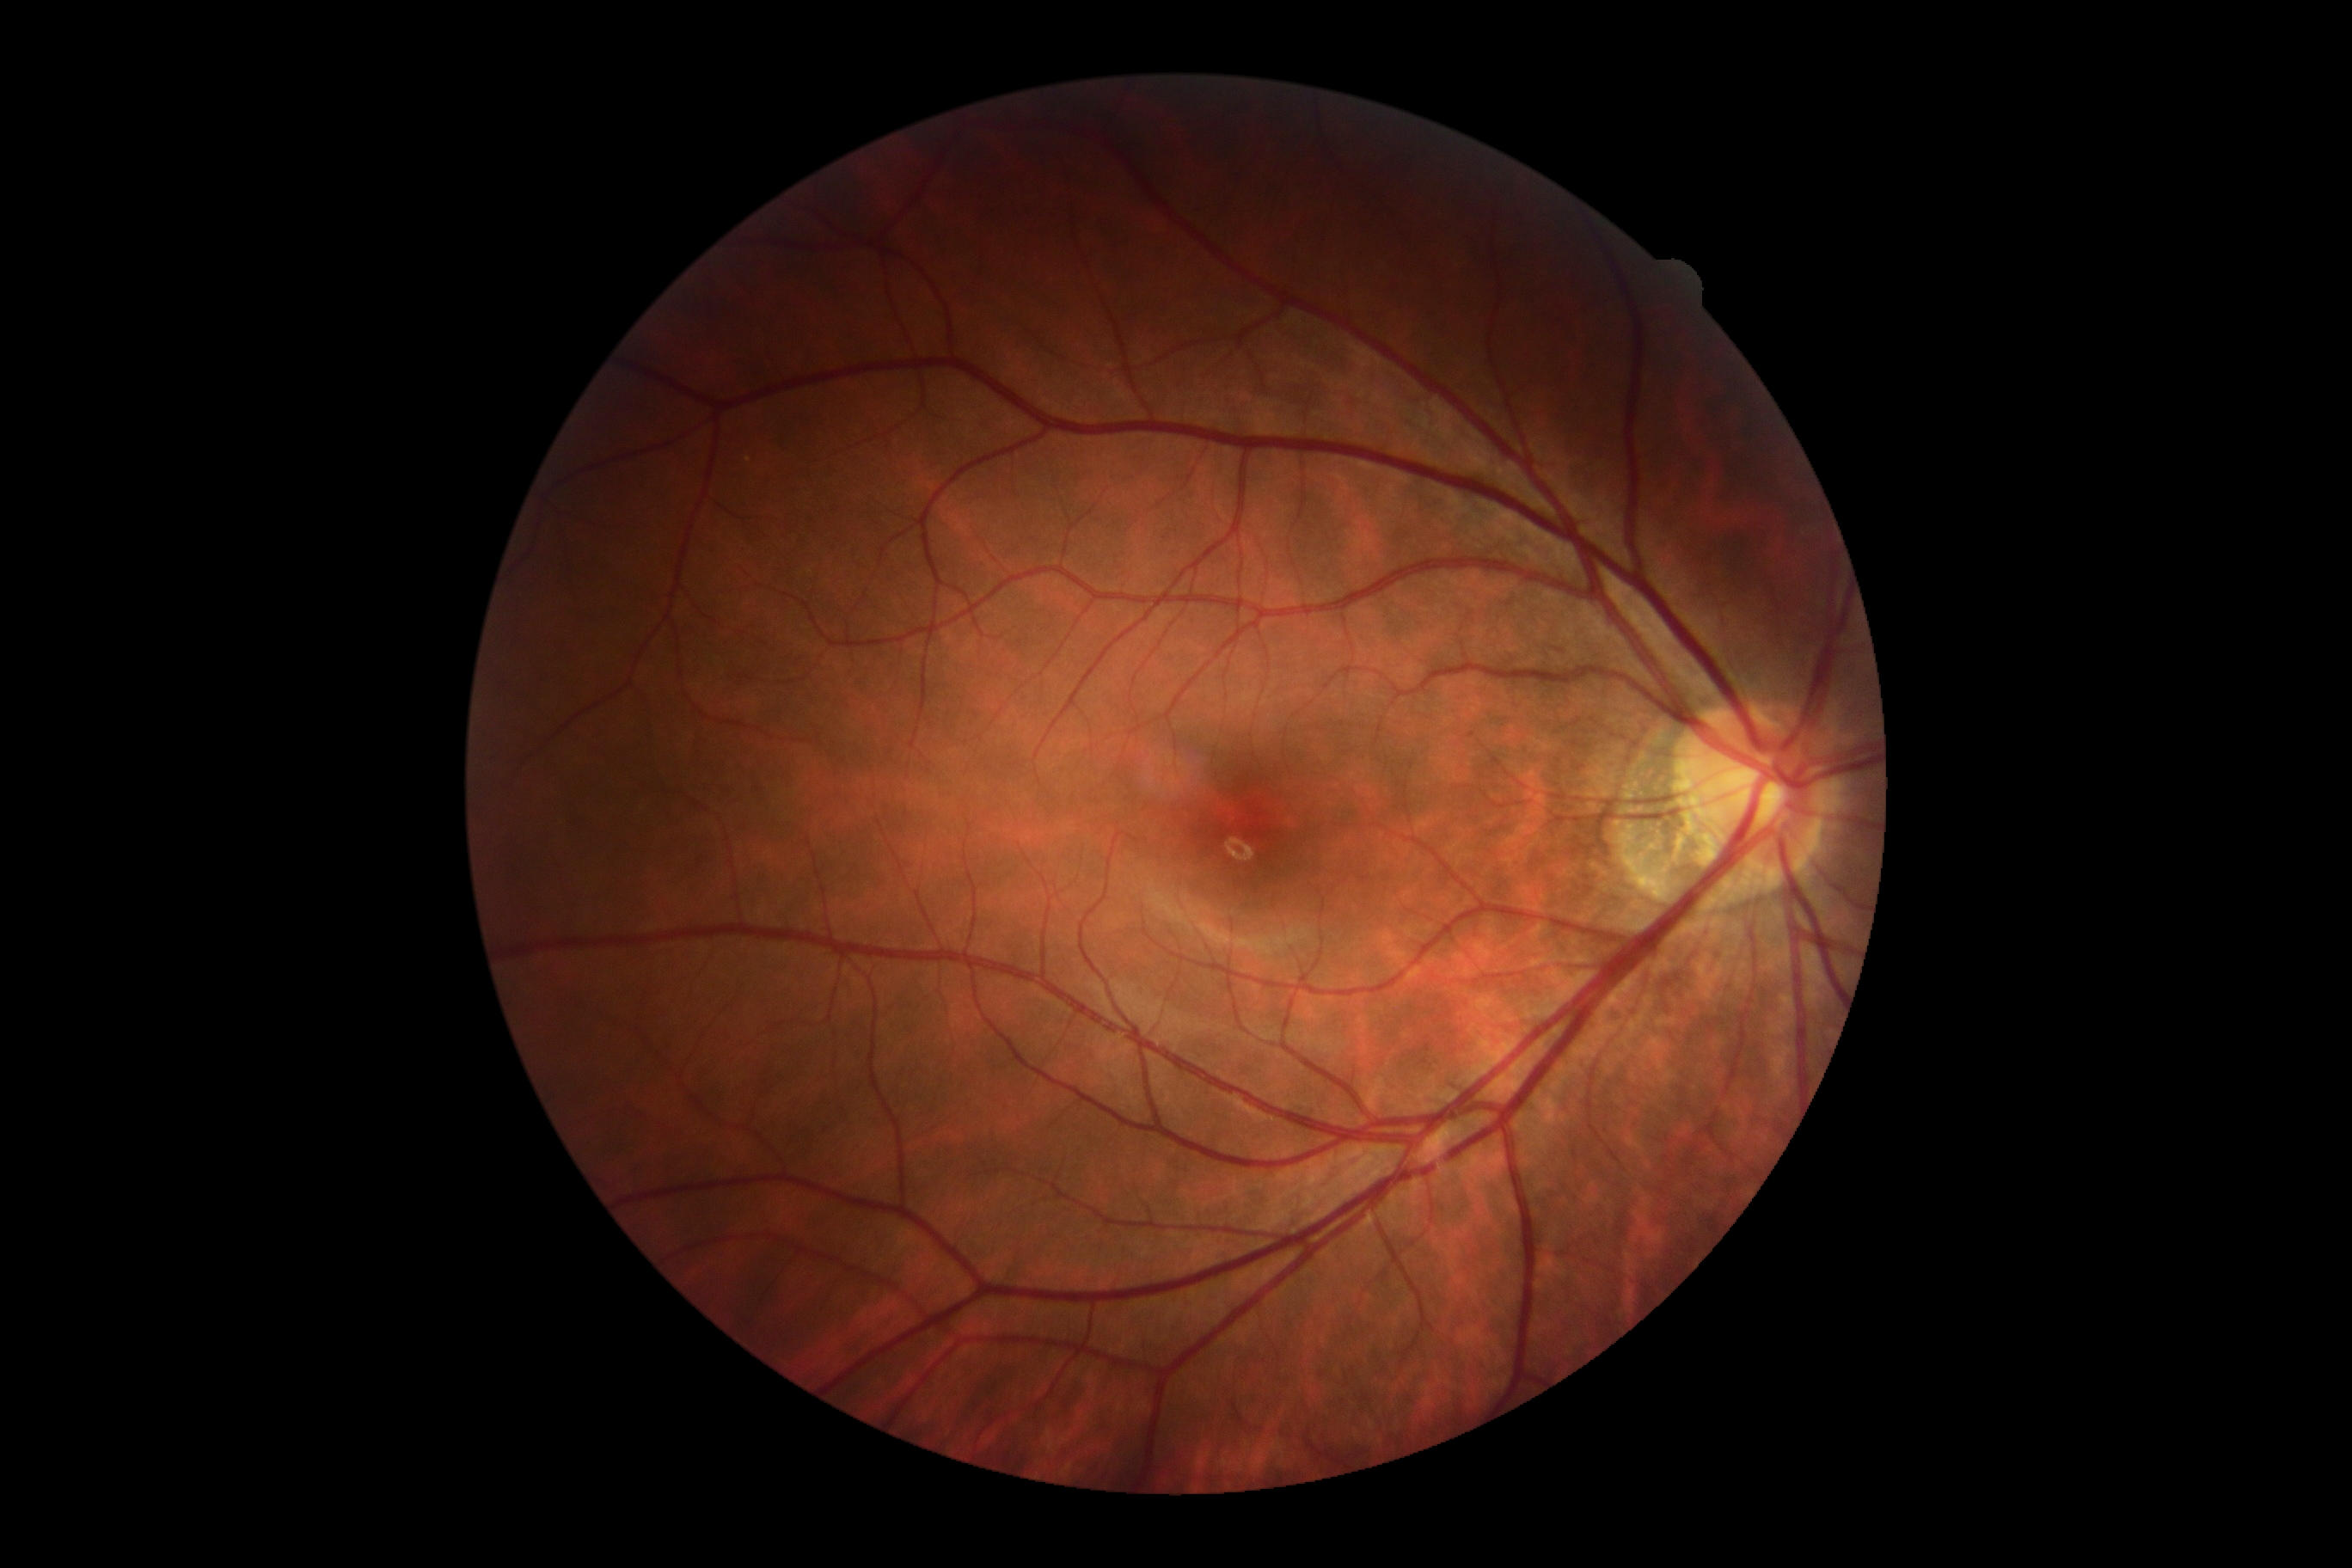
DR severity is grade 0 (no apparent retinopathy) — no visible signs of diabetic retinopathy. No diabetic retinal disease findings.